45° FOV; color fundus image; camera: NIDEK AFC-230; 848 by 848 pixels; nonmydriatic: 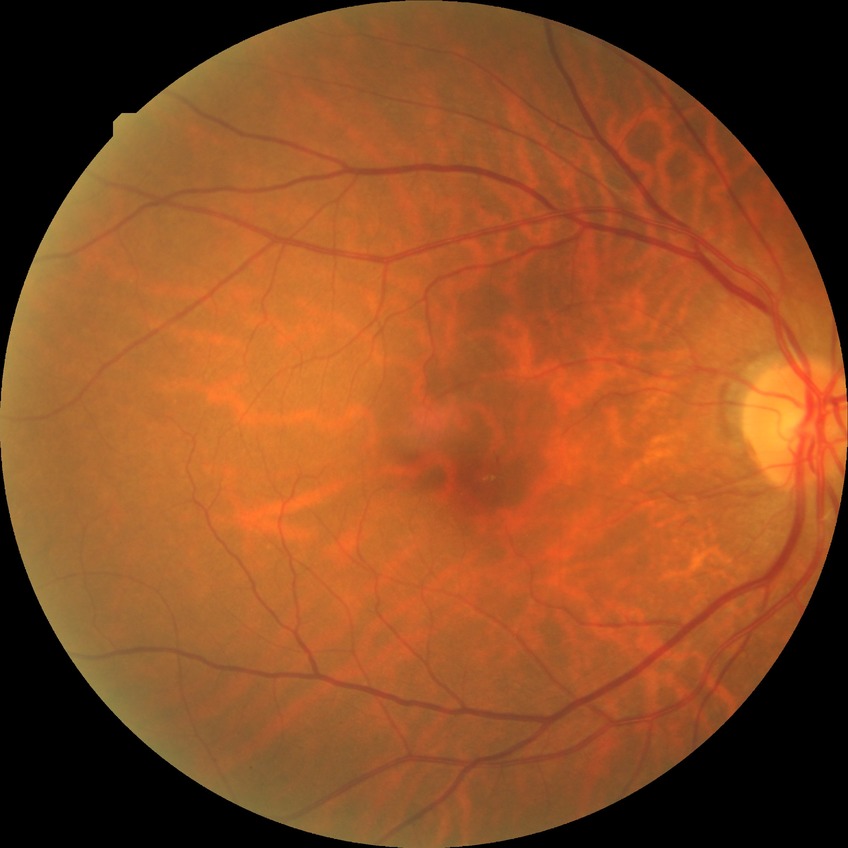
Retinopathy stage: no diabetic retinopathy.